848x848: 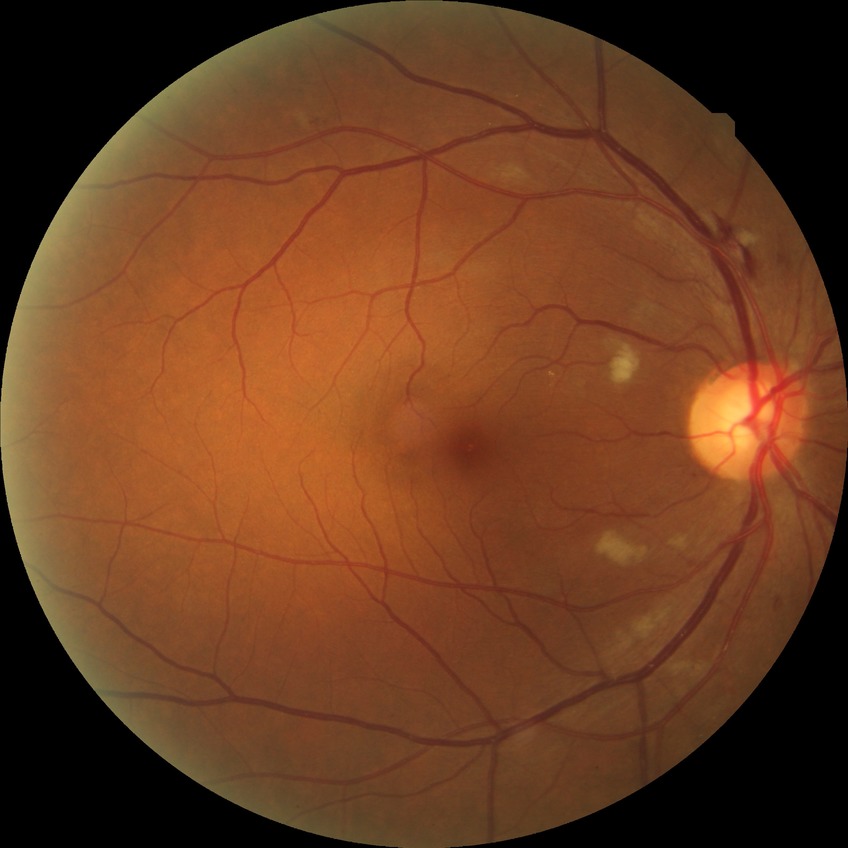 Diabetic retinopathy (DR): PPDR (pre-proliferative diabetic retinopathy).